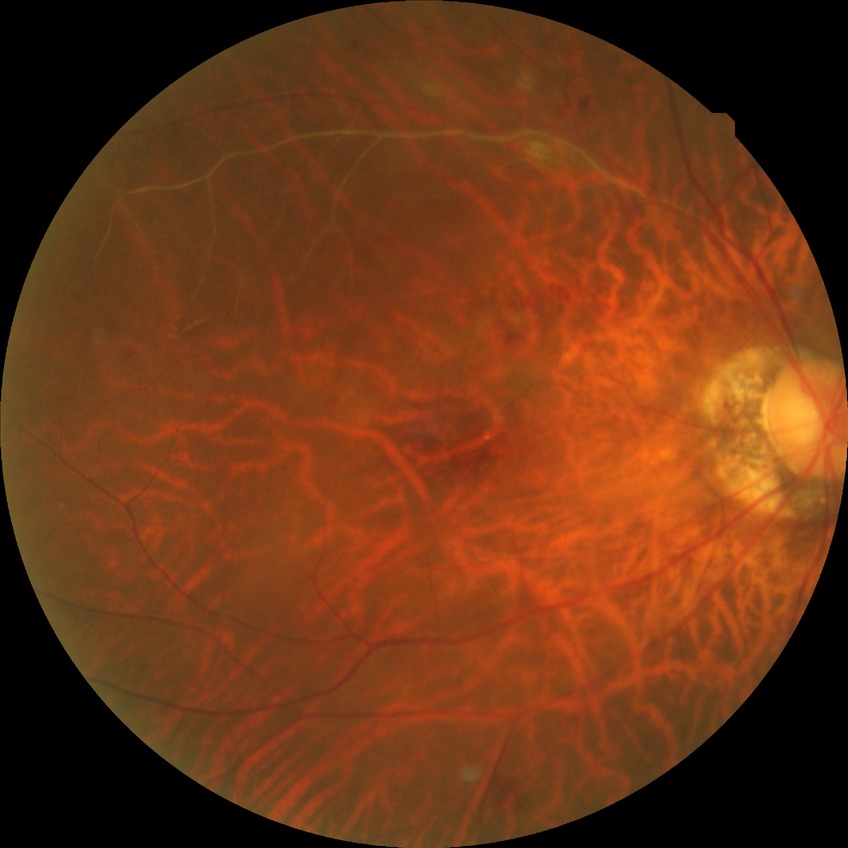
diabetic retinopathy (DR)=no diabetic retinopathy (NDR).